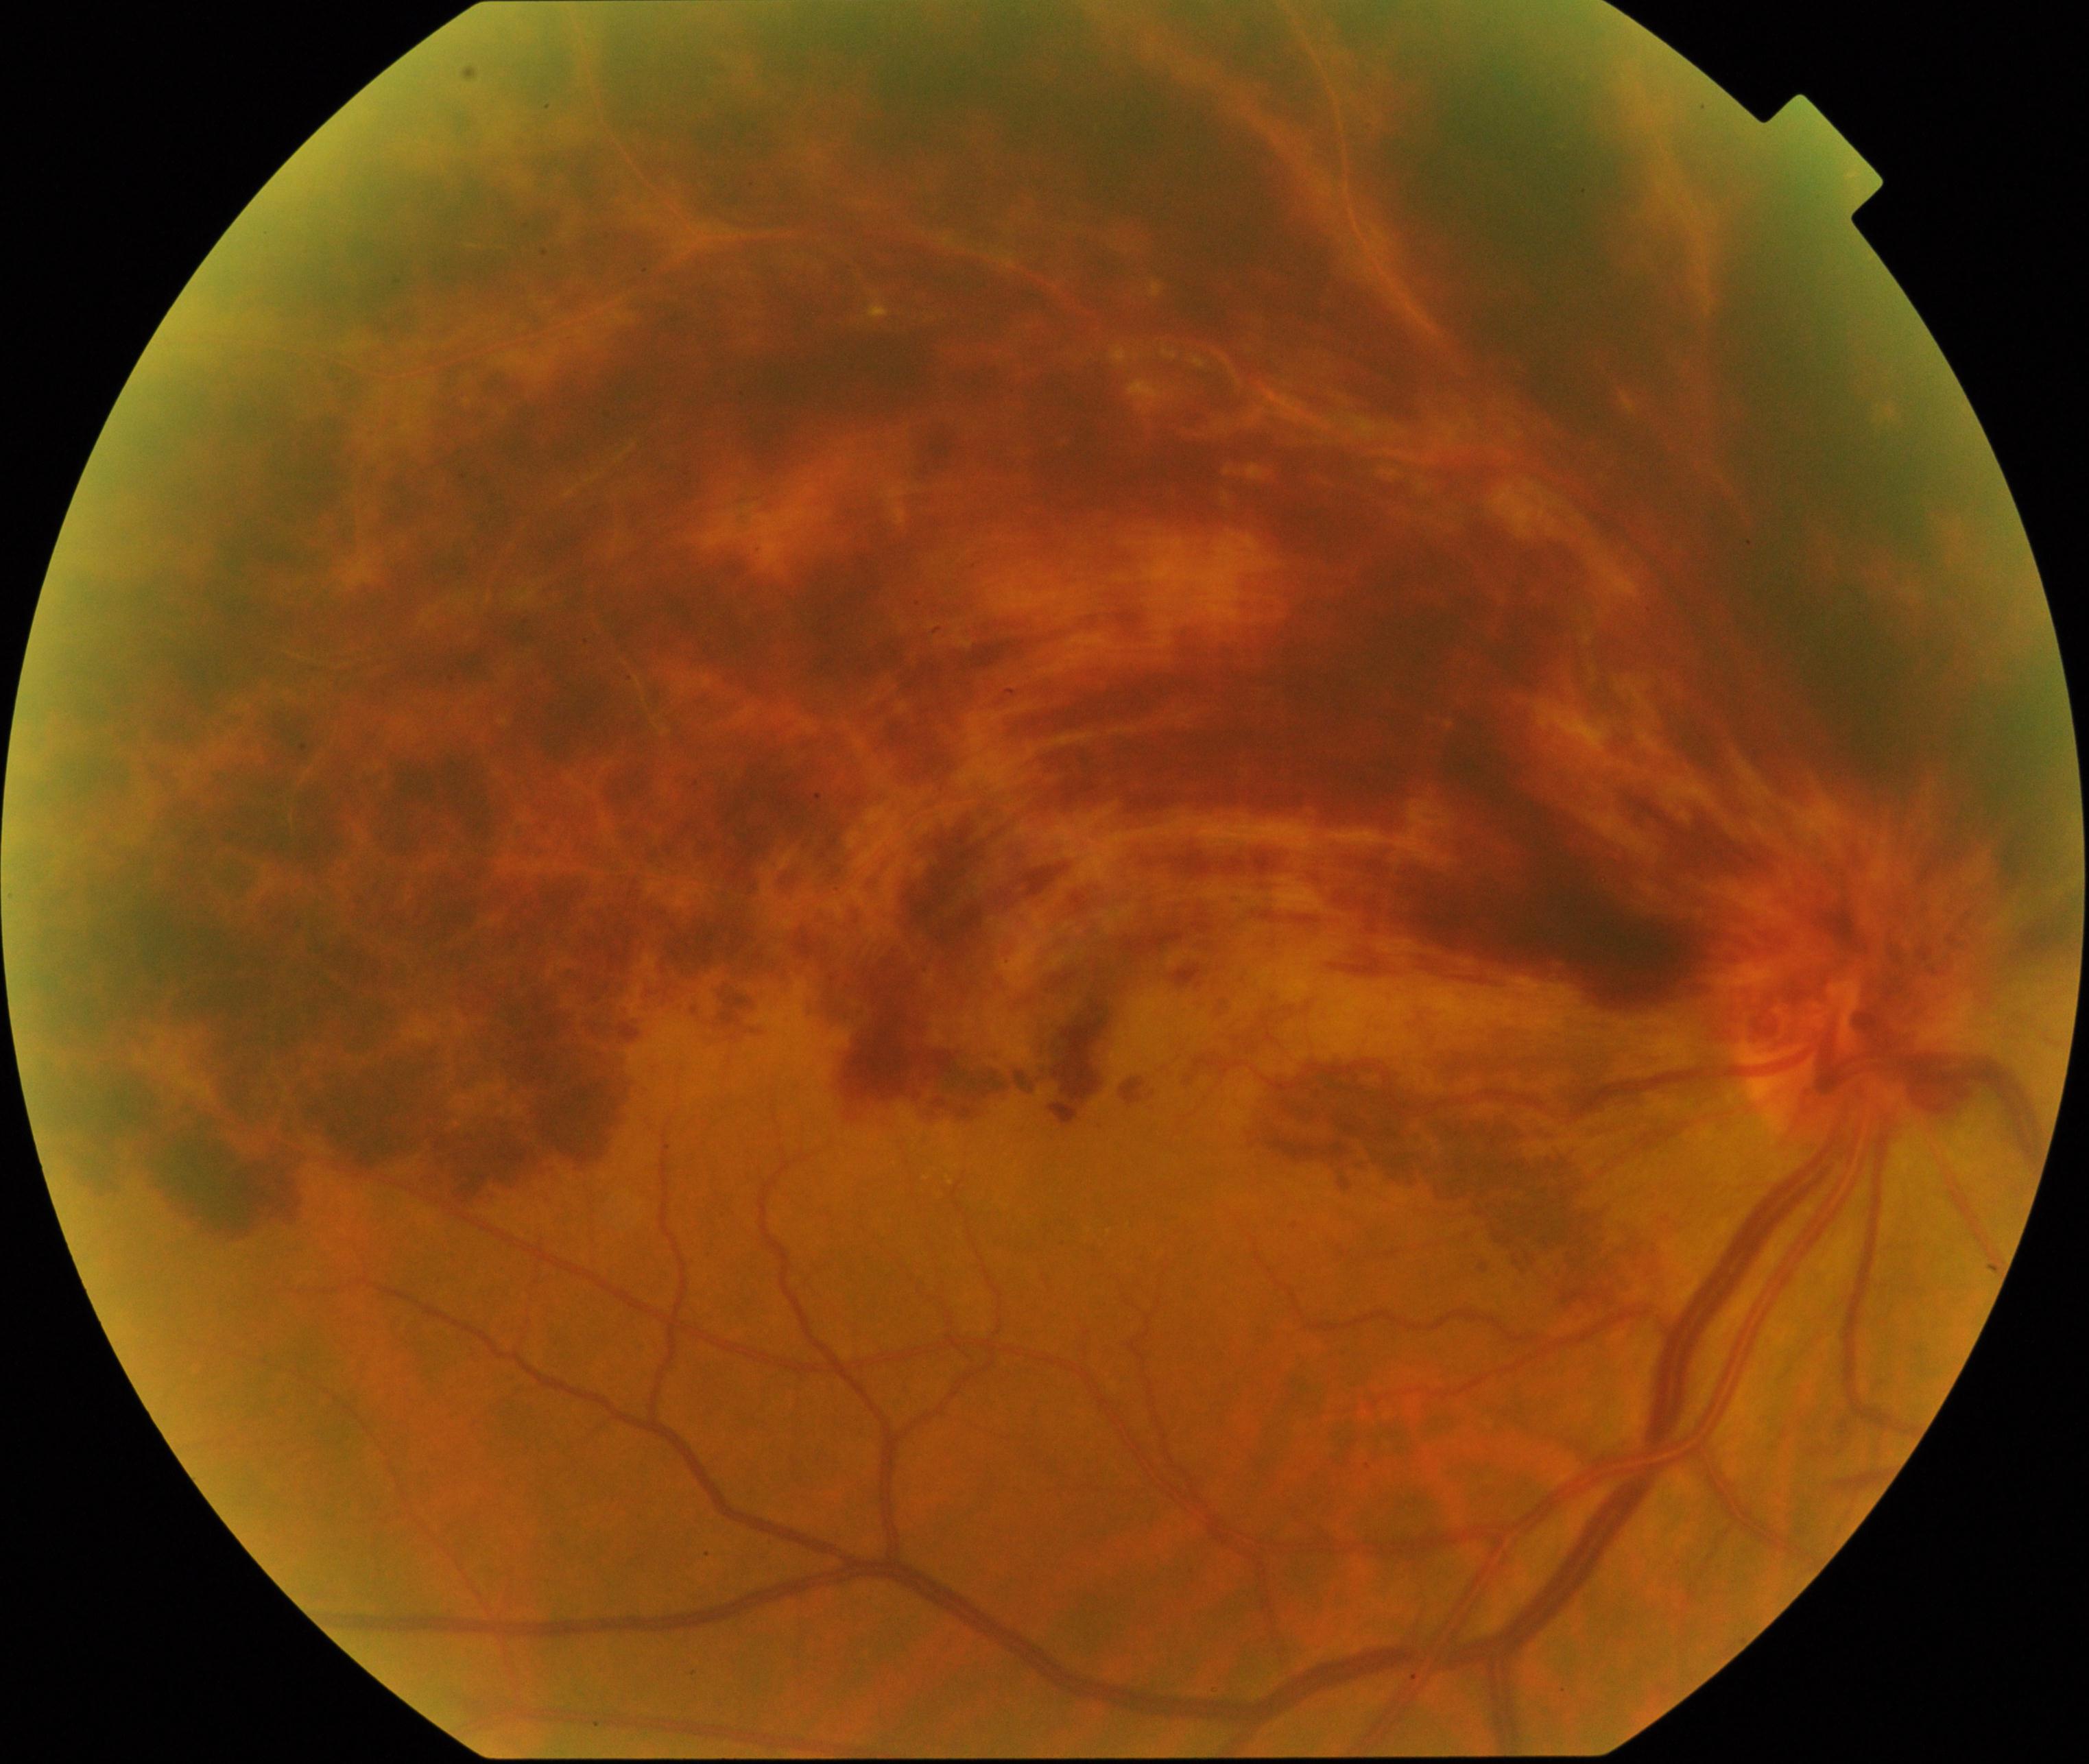
Consistent with branch retinal vein occlusion.